Color fundus image; 1470 x 1137 pixels — 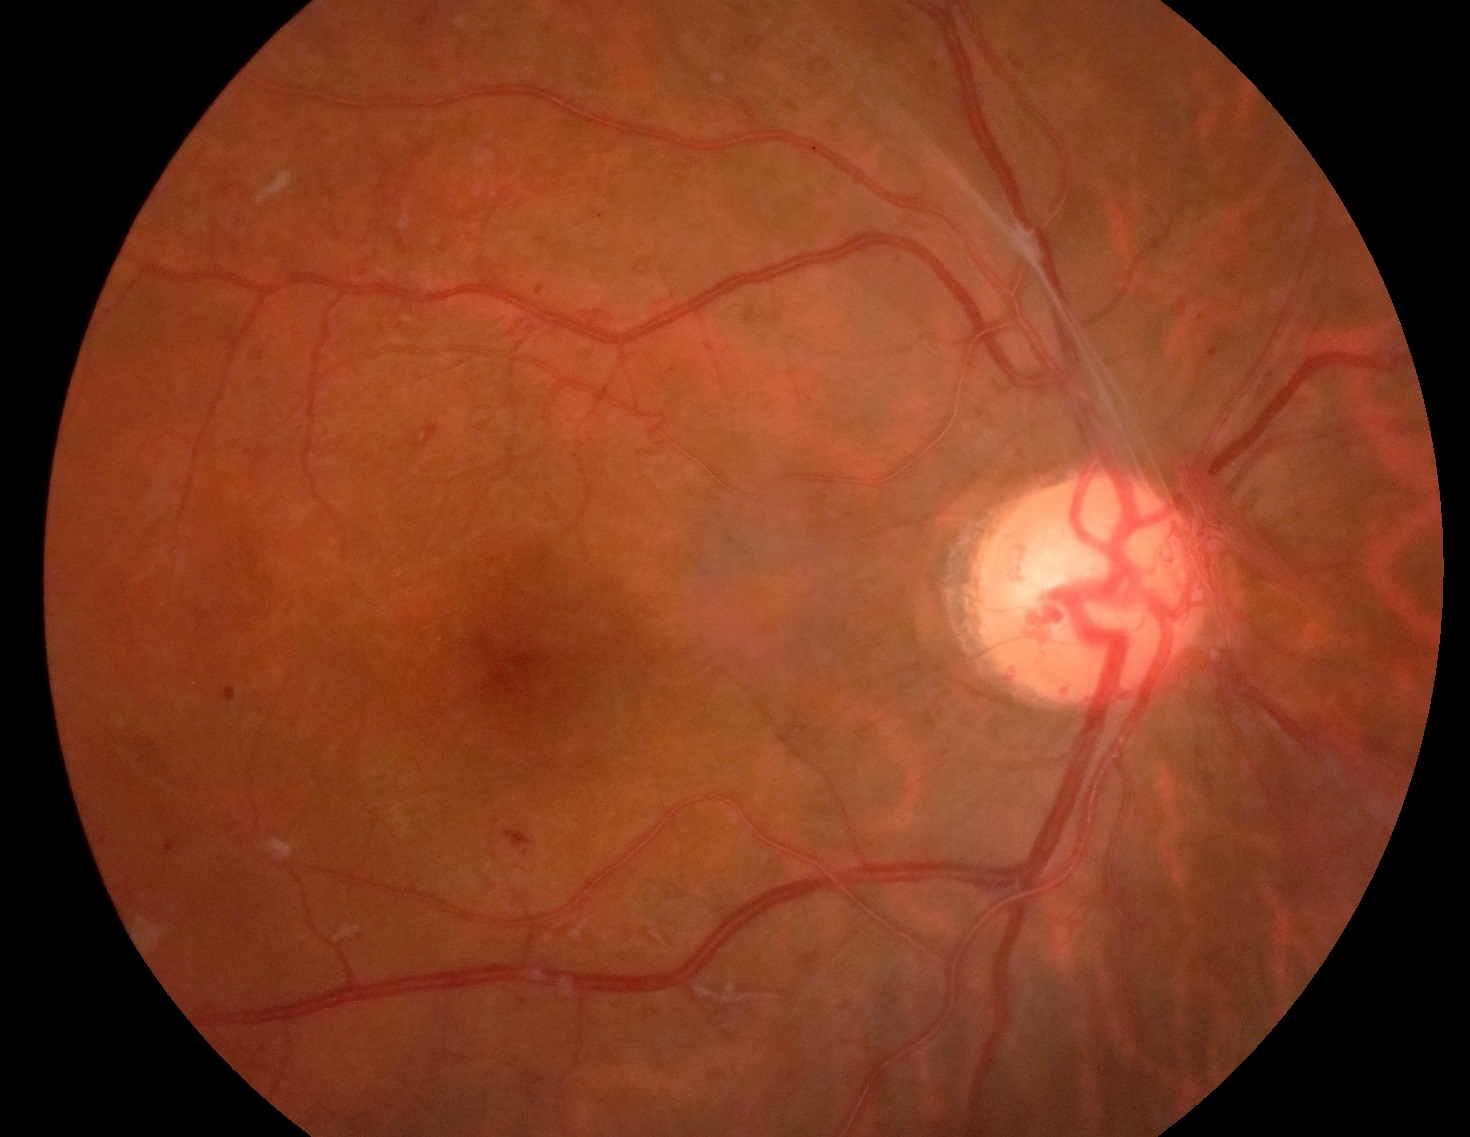 Findings:
* diabetic retinopathy grade — PDR (4)